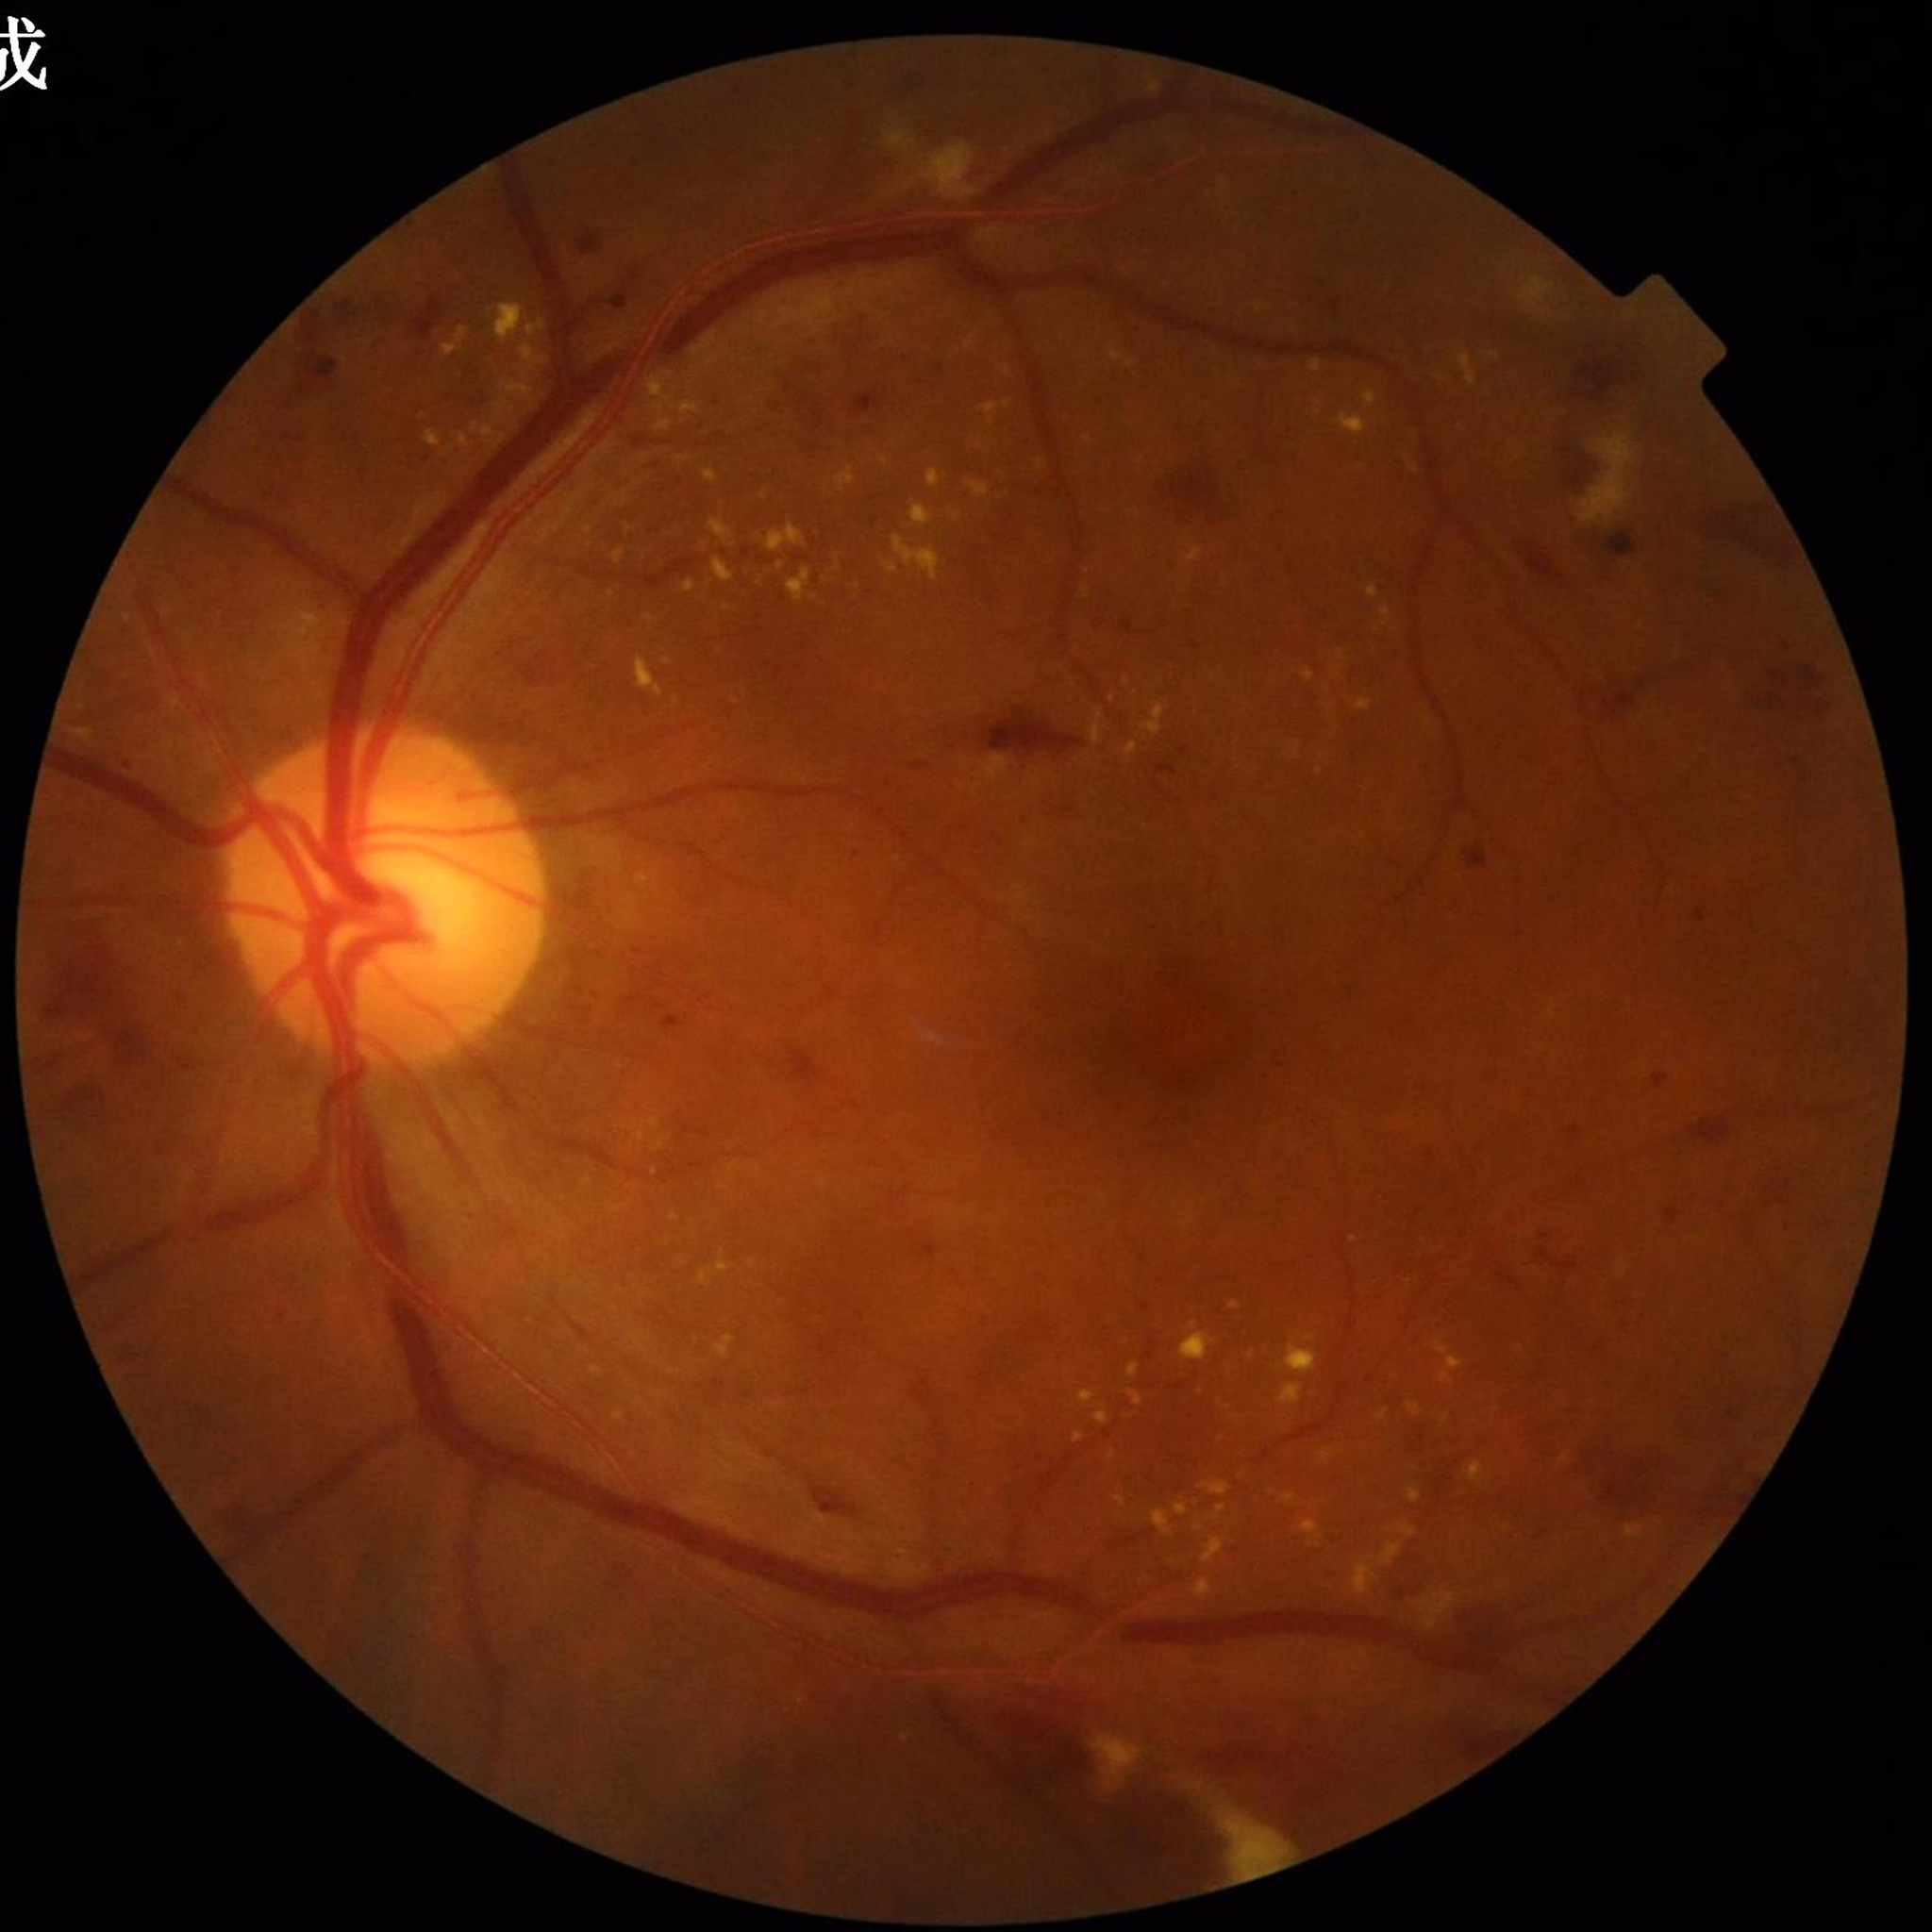 Disease = diabetic retinopathy.